Wide-field fundus photograph of an infant. Phoenix ICON, 100° FOV.
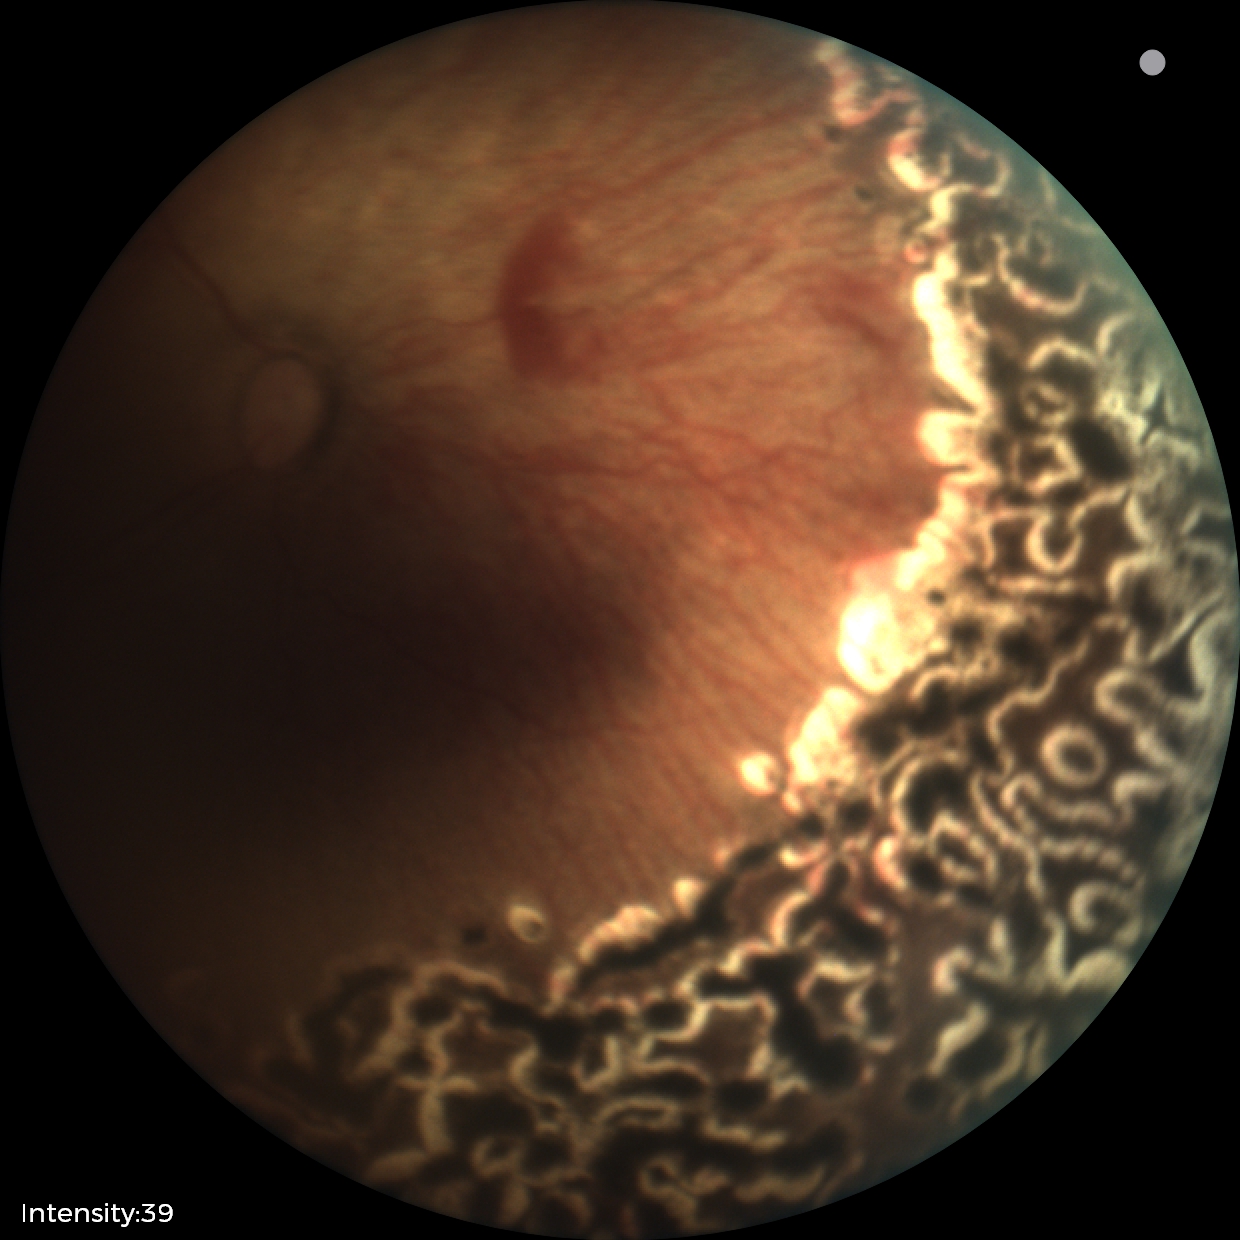

Impression: status post retinopathy of prematurity; no plus disease.